Nonmydriatic fundus photograph · 848x848px.
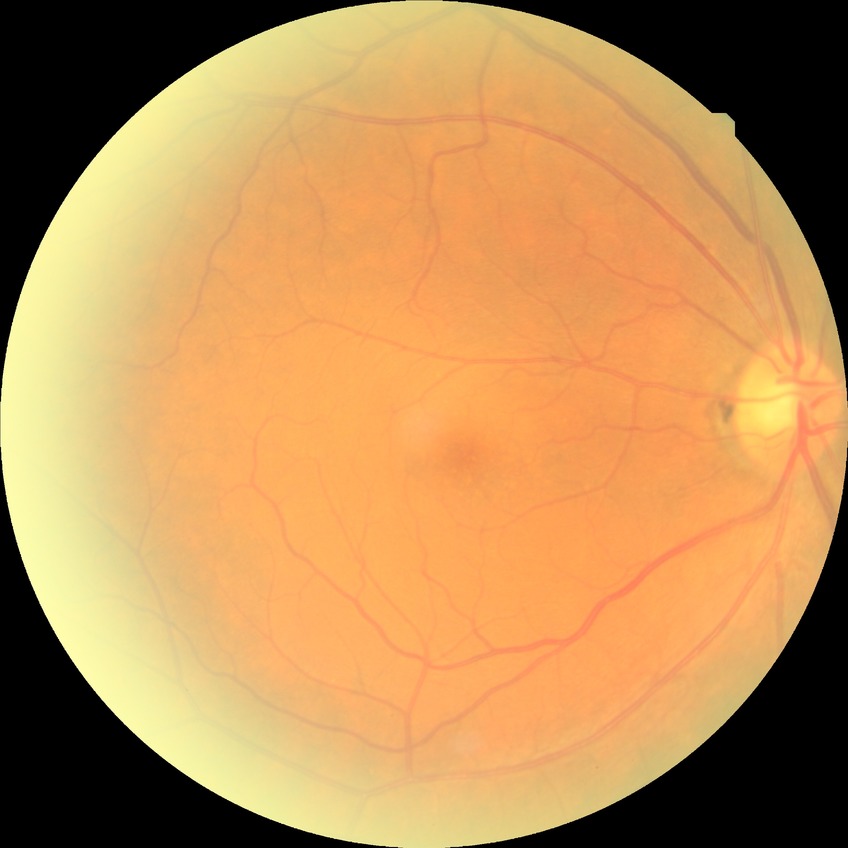
Davis grade: NDR.